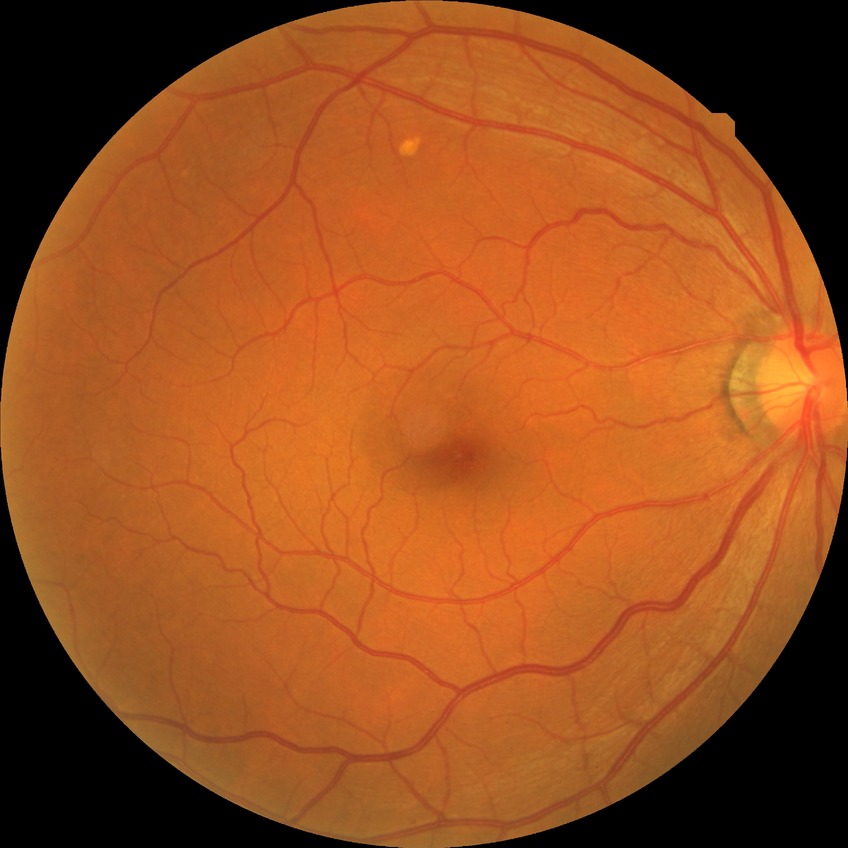
diabetic retinopathy (DR): no diabetic retinopathy (NDR).